RetCam wide-field infant fundus image. 640x480px
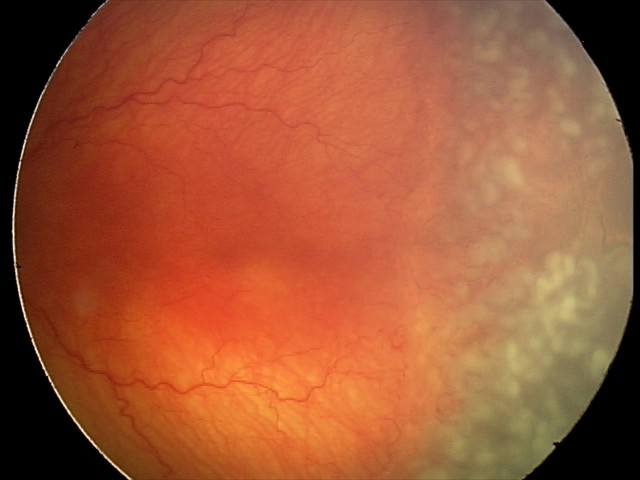
Screening diagnosis: aggressive retinopathy of prematurity (A-ROP) — rapidly progressive severe ROP with prominent plus disease, often without classic stage progression; plus disease.